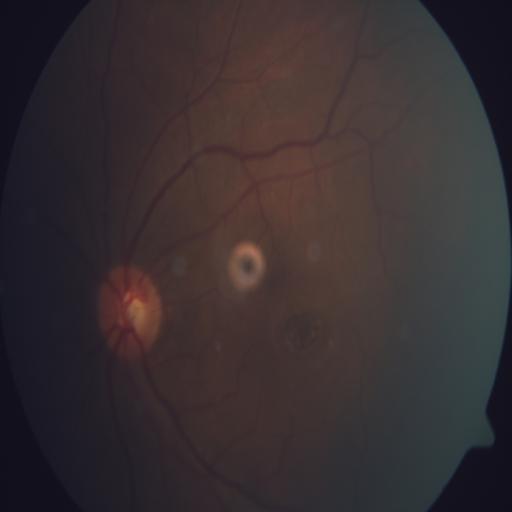 Diagnoses: macular hole.